45-degree field of view, modified Davis classification, image size 848x848, camera: NIDEK AFC-230
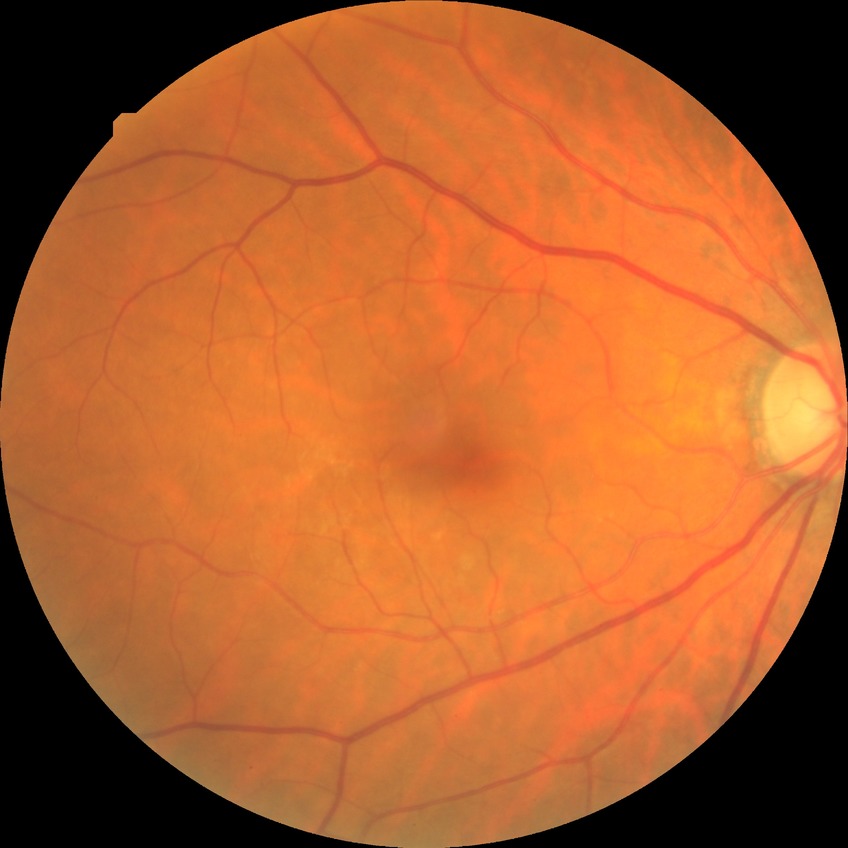

{
  "davis_grade": "NDR"
}